Fundus photo; 45° field of view; 2352x1568px.
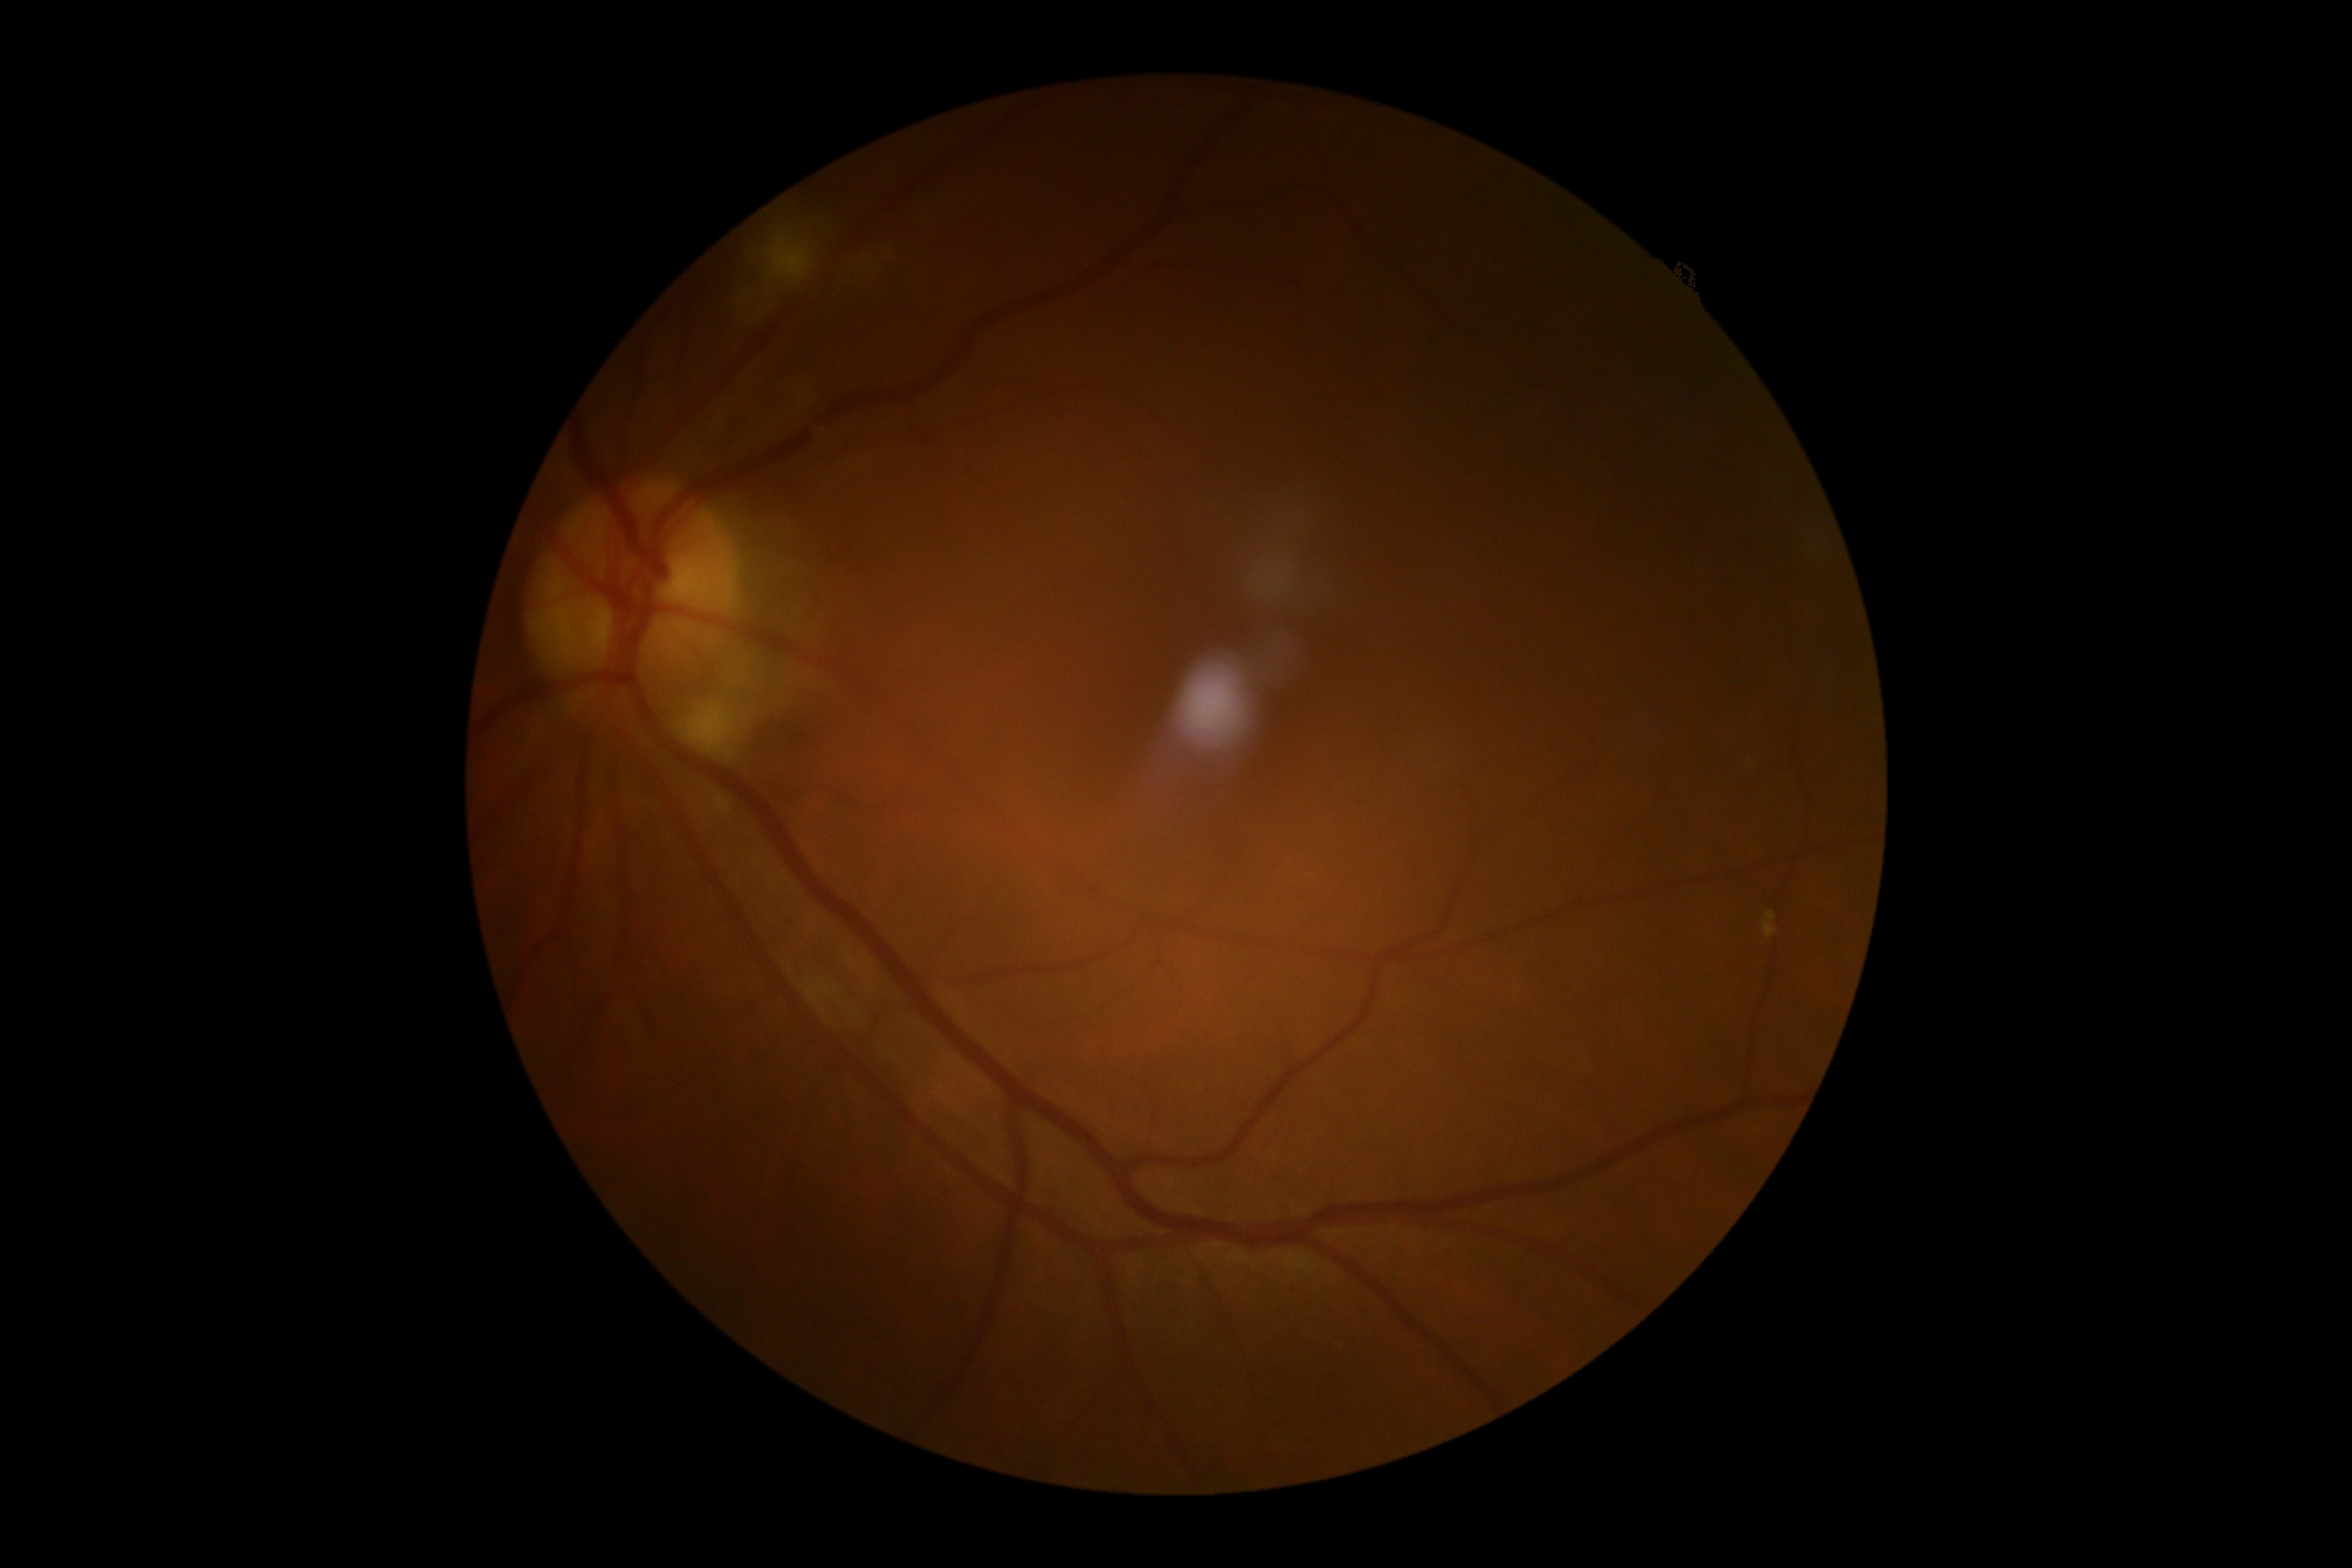

DR is 2/4.